Retinal fundus photograph.
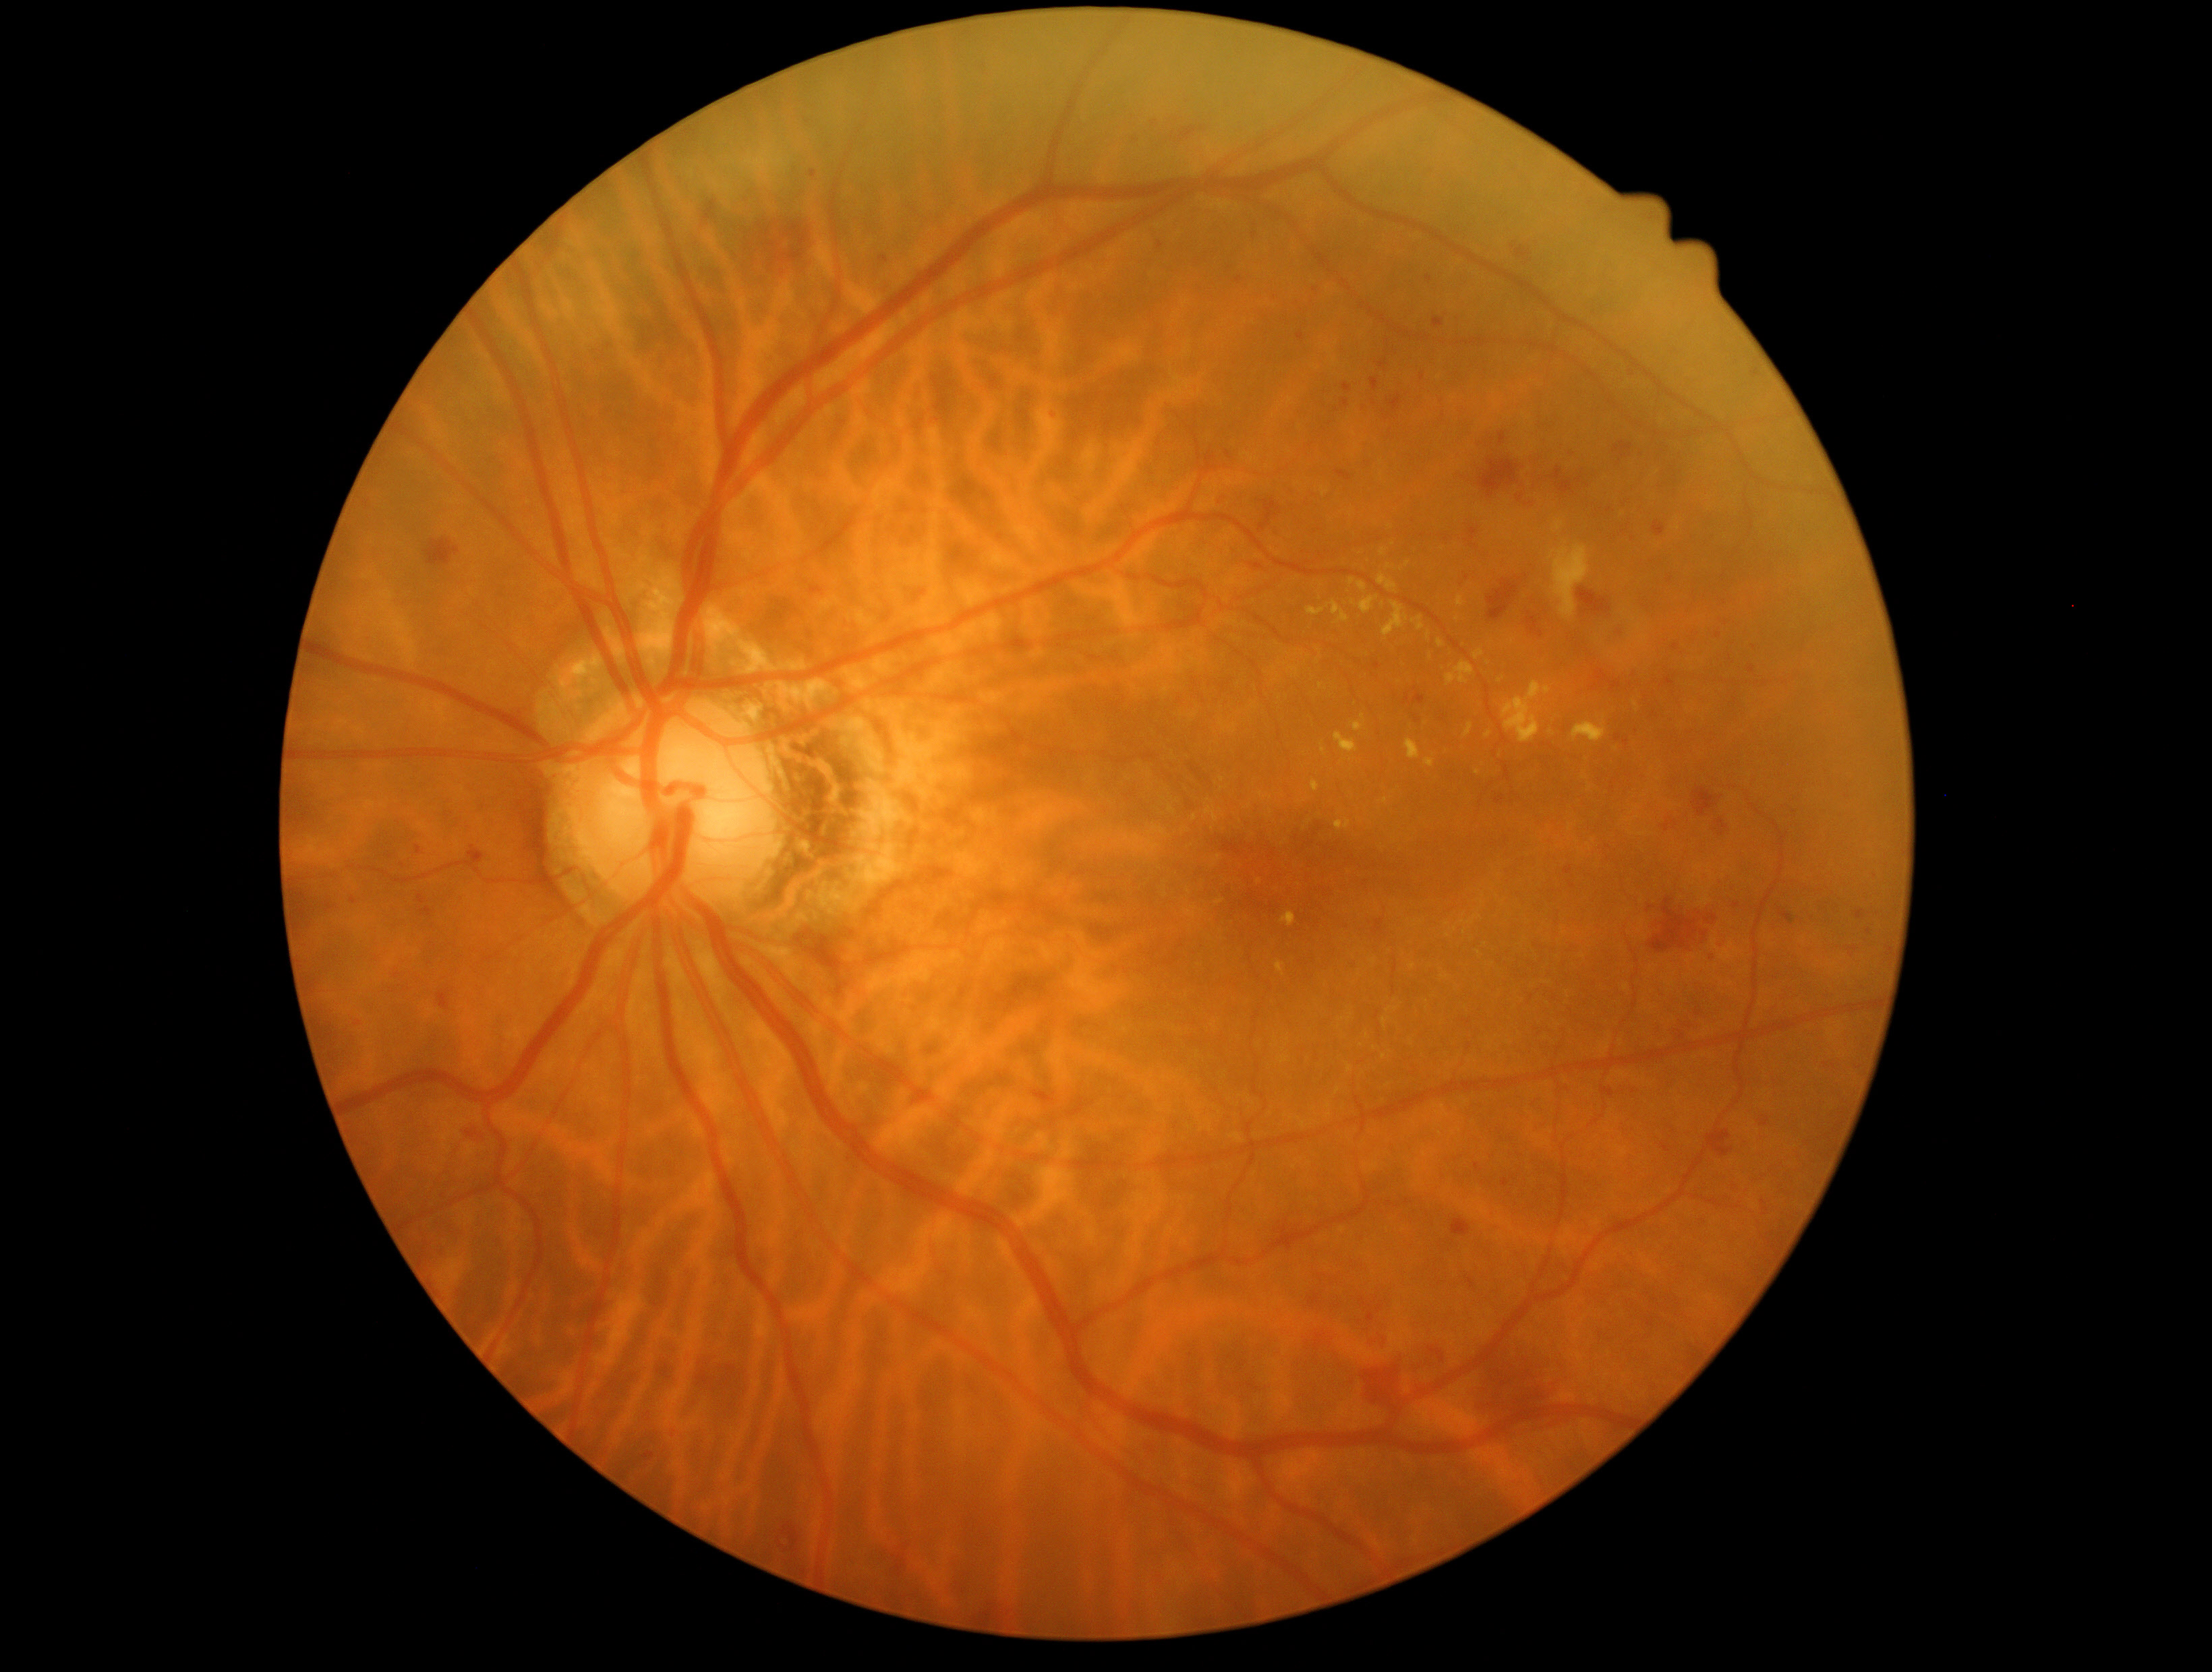
DR severity is 2/4; non-proliferative diabetic retinopathy
A subset of detected lesions:
HEs (continued): rect(880, 257, 890, 264), rect(1015, 1195, 1023, 1203), rect(1337, 471, 1352, 482), rect(1710, 815, 1731, 841), rect(1619, 498, 1633, 512), rect(1608, 625, 1623, 644), rect(1378, 361, 1389, 370), rect(1515, 247, 1530, 262), rect(973, 1608, 1001, 1623), rect(1700, 1121, 1735, 1160), rect(829, 412, 849, 451), rect(1343, 384, 1352, 393), rect(1032, 1092, 1055, 1106)
Additional small HEs near (x=1228, y=455), (x=1632, y=373), (x=1629, y=777), (x=1443, y=718), (x=1794, y=813)